Posterior pole color fundus photograph · modified Davis classification:
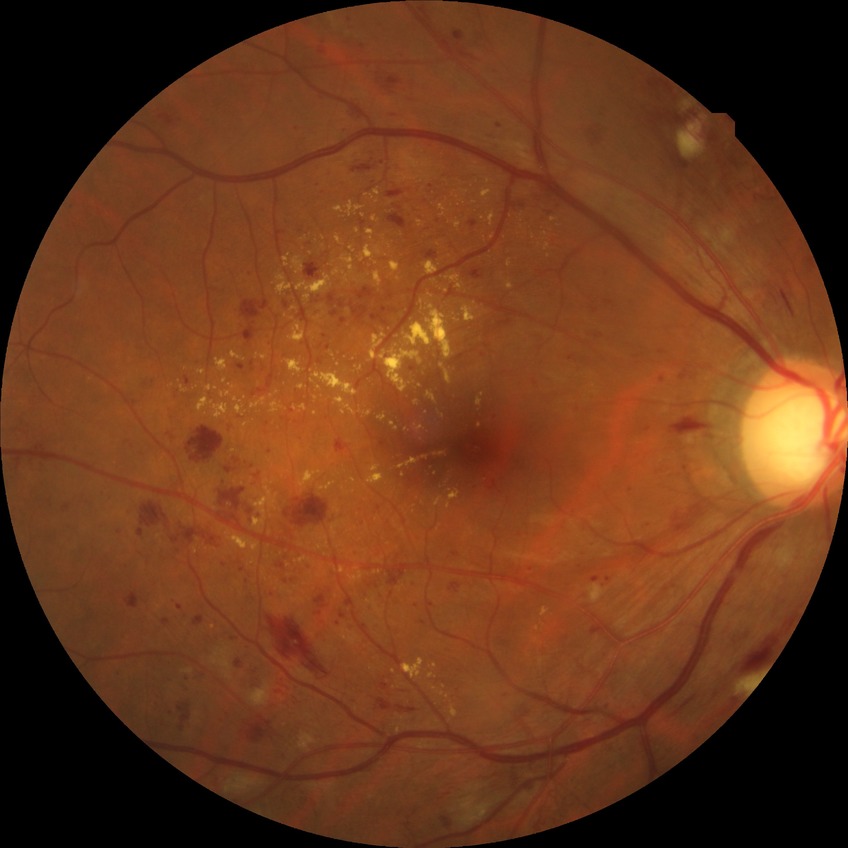   davis_grade: pre-proliferative diabetic retinopathy